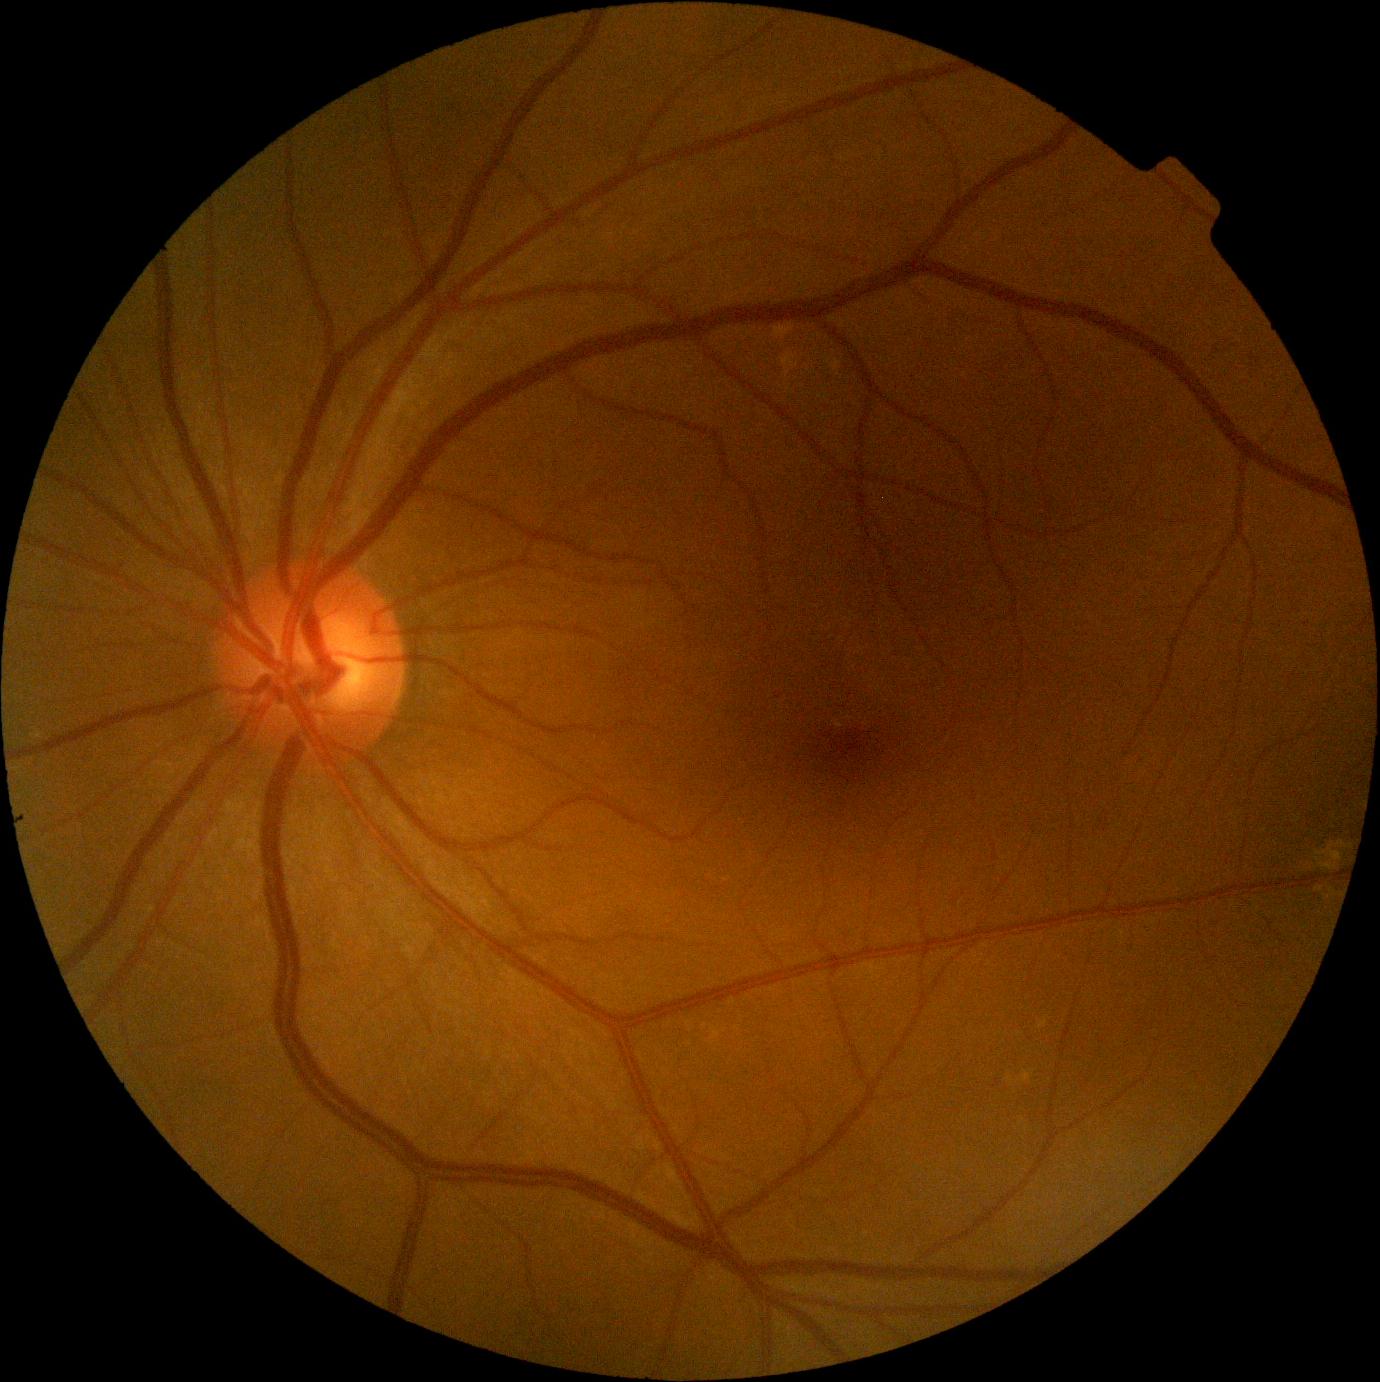
DR is 0 — no visible signs of diabetic retinopathy. No DR findings.